848 by 848 pixels · modified Davis grading · NIDEK AFC-230 · without pupil dilation
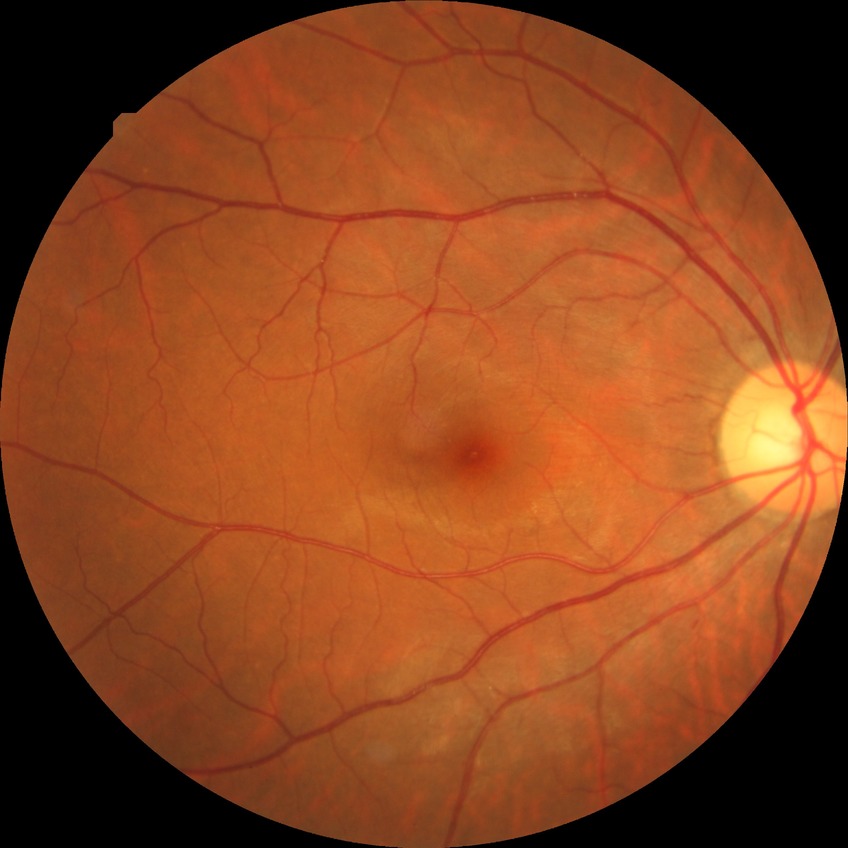

Diabetic retinopathy grade: no diabetic retinopathy.